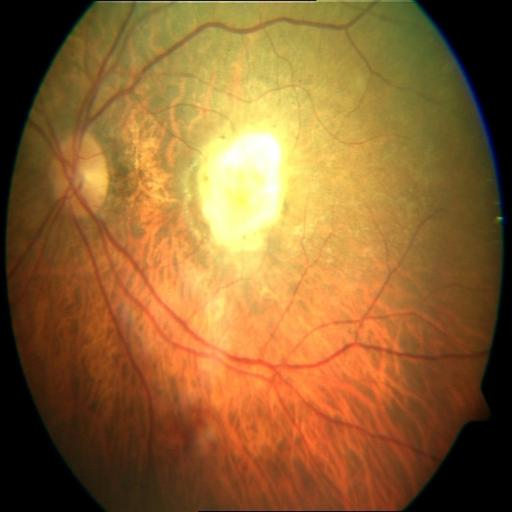

Impression: CRS (chorioretinitis), MYA (myopia).